NIDEK AFC-230 fundus camera, nonmydriatic
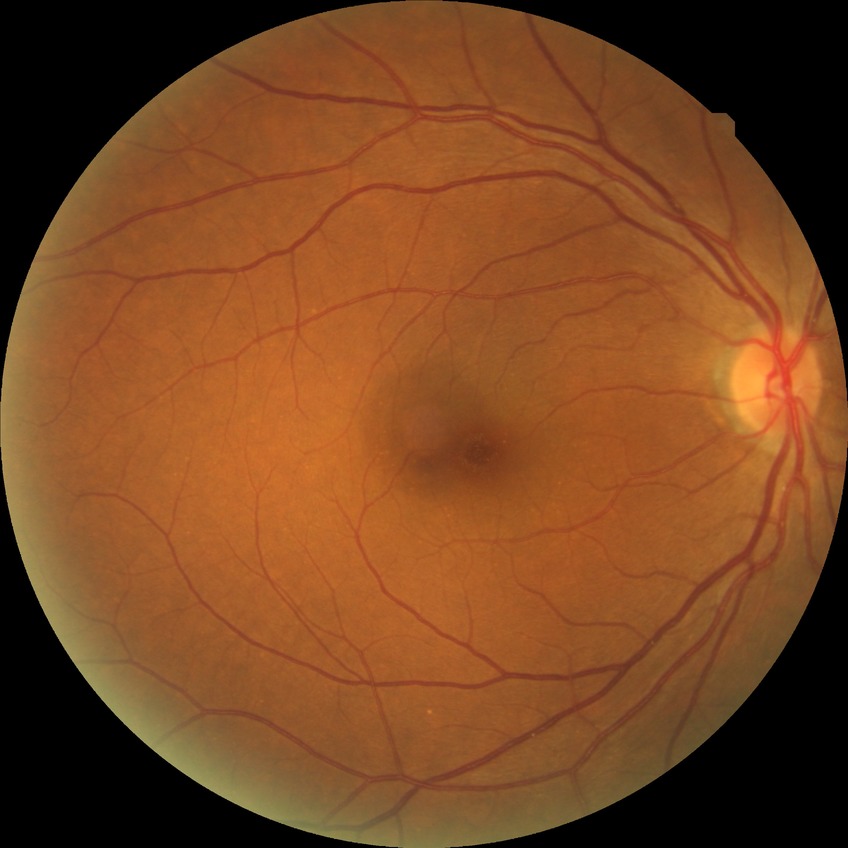
Annotations:
* diabetic retinopathy (DR) — NDR (no diabetic retinopathy)